FOV: 45 degrees; 1932x1910; color fundus photograph
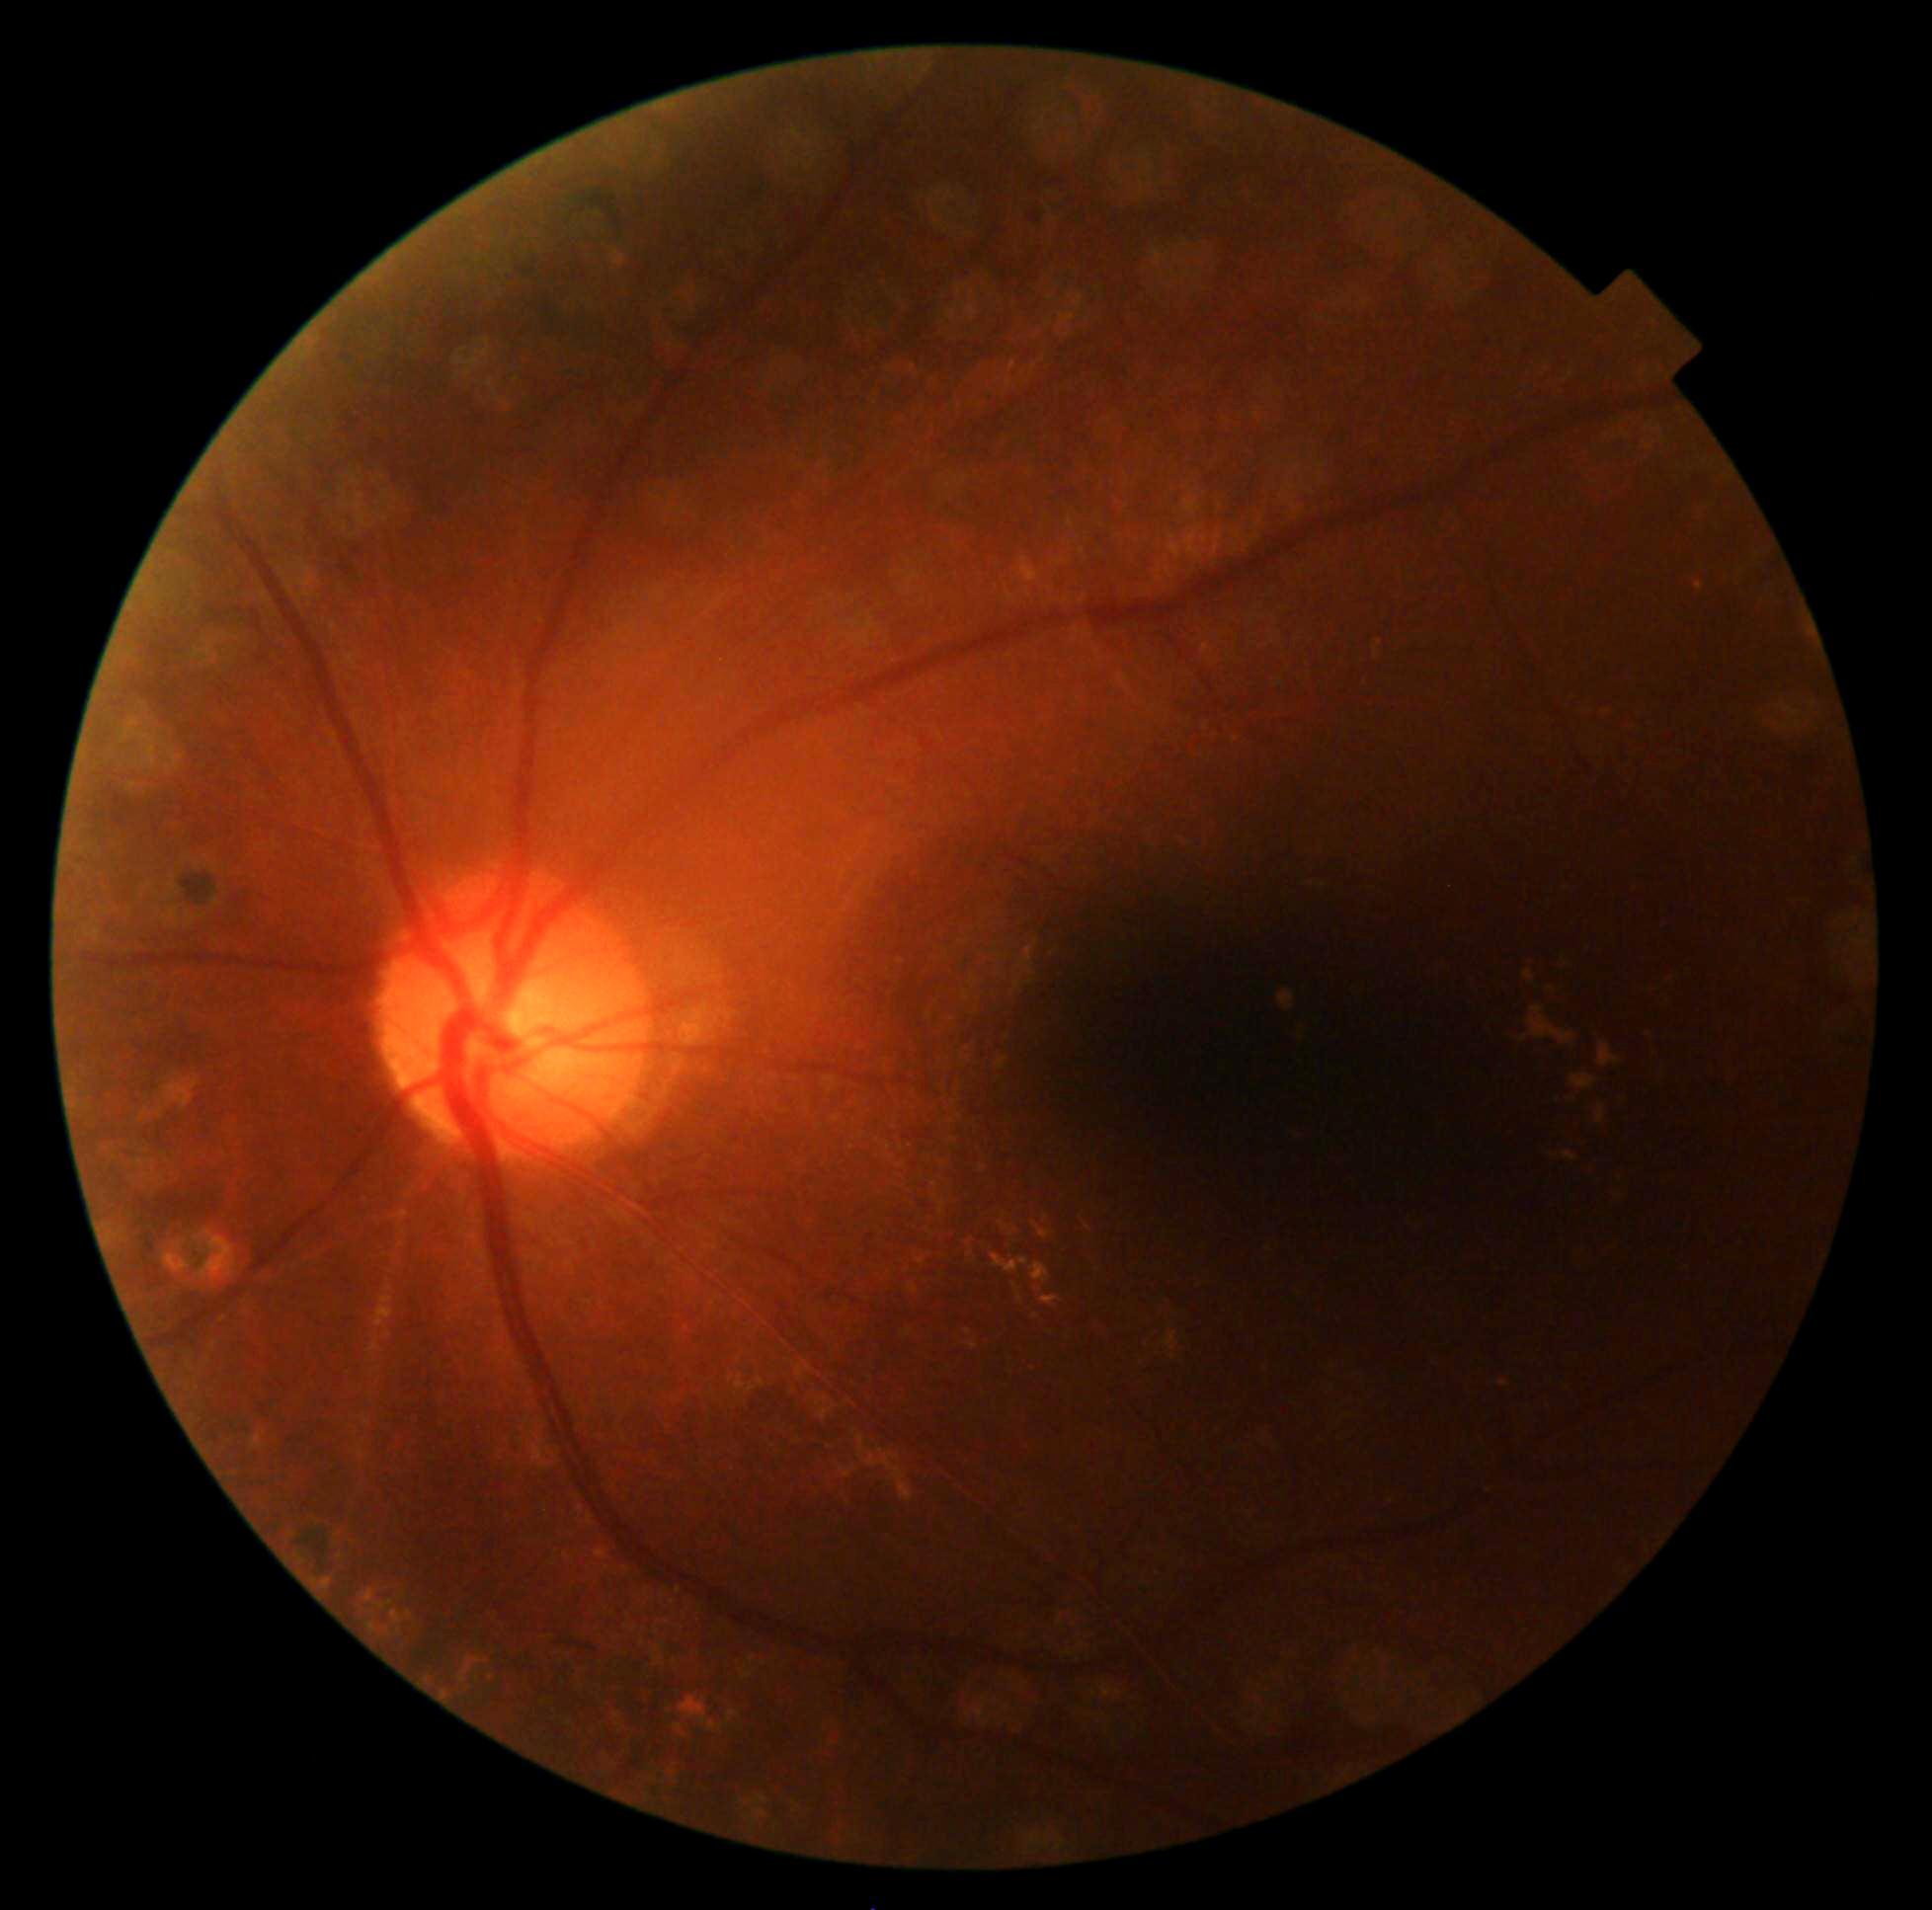

{"dr_grade": "grade 2 (moderate NPDR)"}